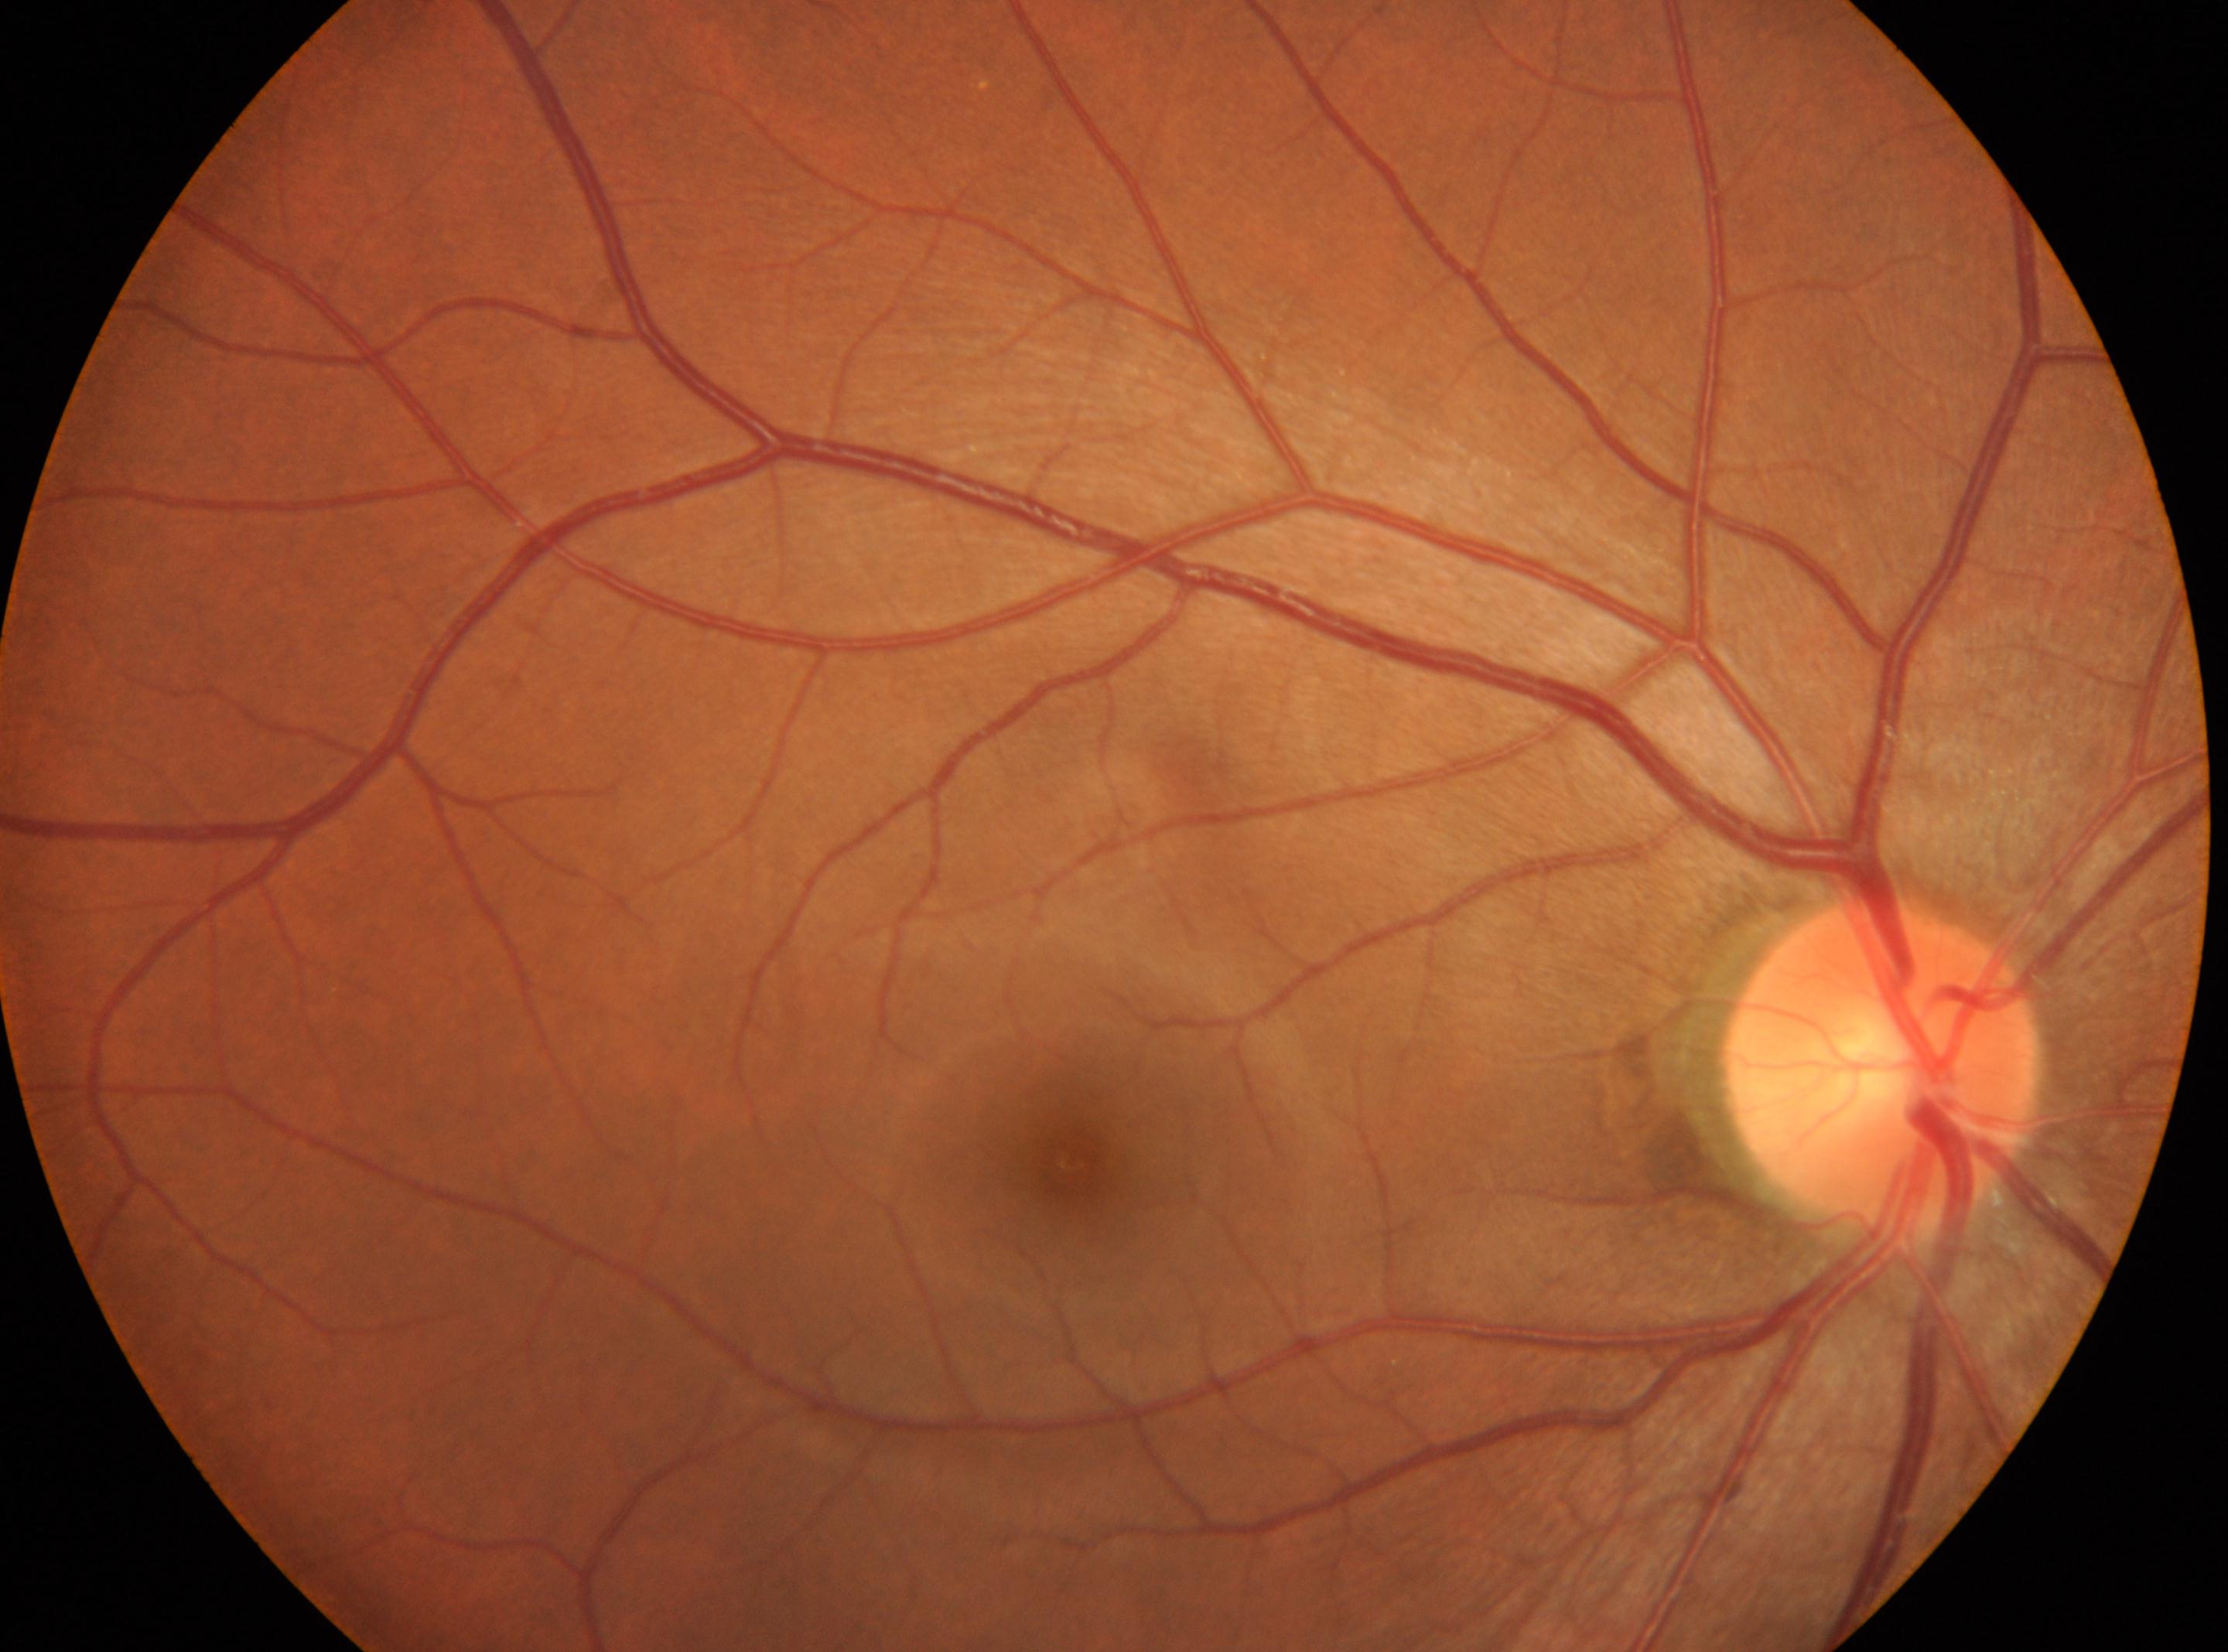

No DR findings. Fovea: [1068, 1163]. ONH located at [1881, 1063]. Retinopathy: grade 0. The image shows the oculus dexter.